Diabetic retinopathy graded by the modified Davis classification; 45-degree field of view.
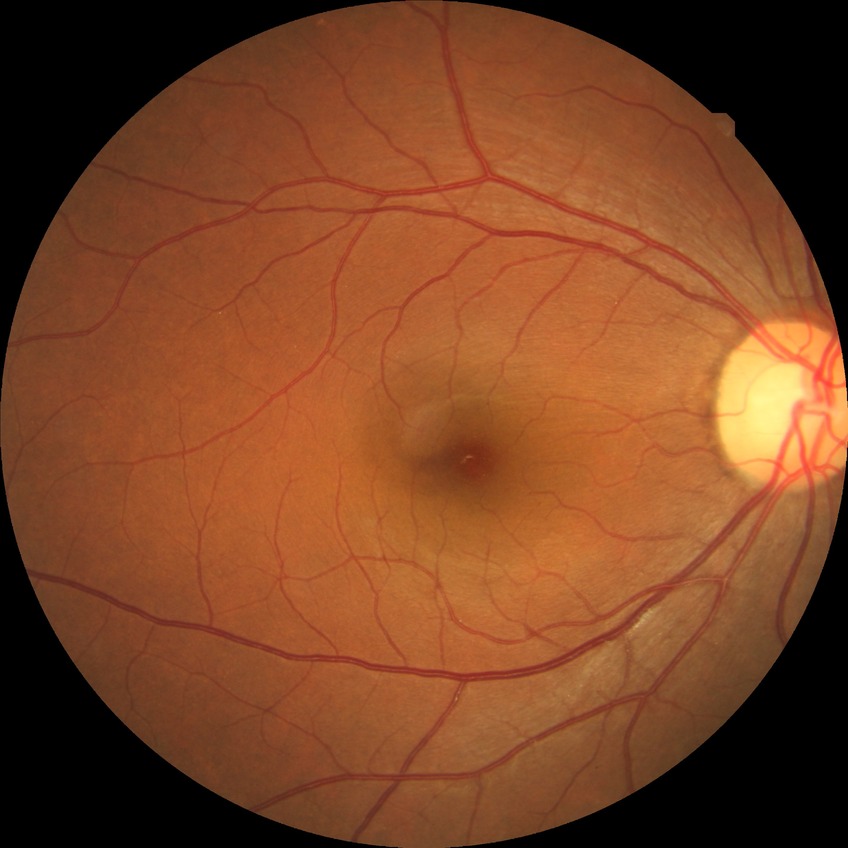

Modified Davis classification: no diabetic retinopathy.